1659 x 2212 pixels. Acquired with a Remidio FOP fundus camera. Color fundus image:
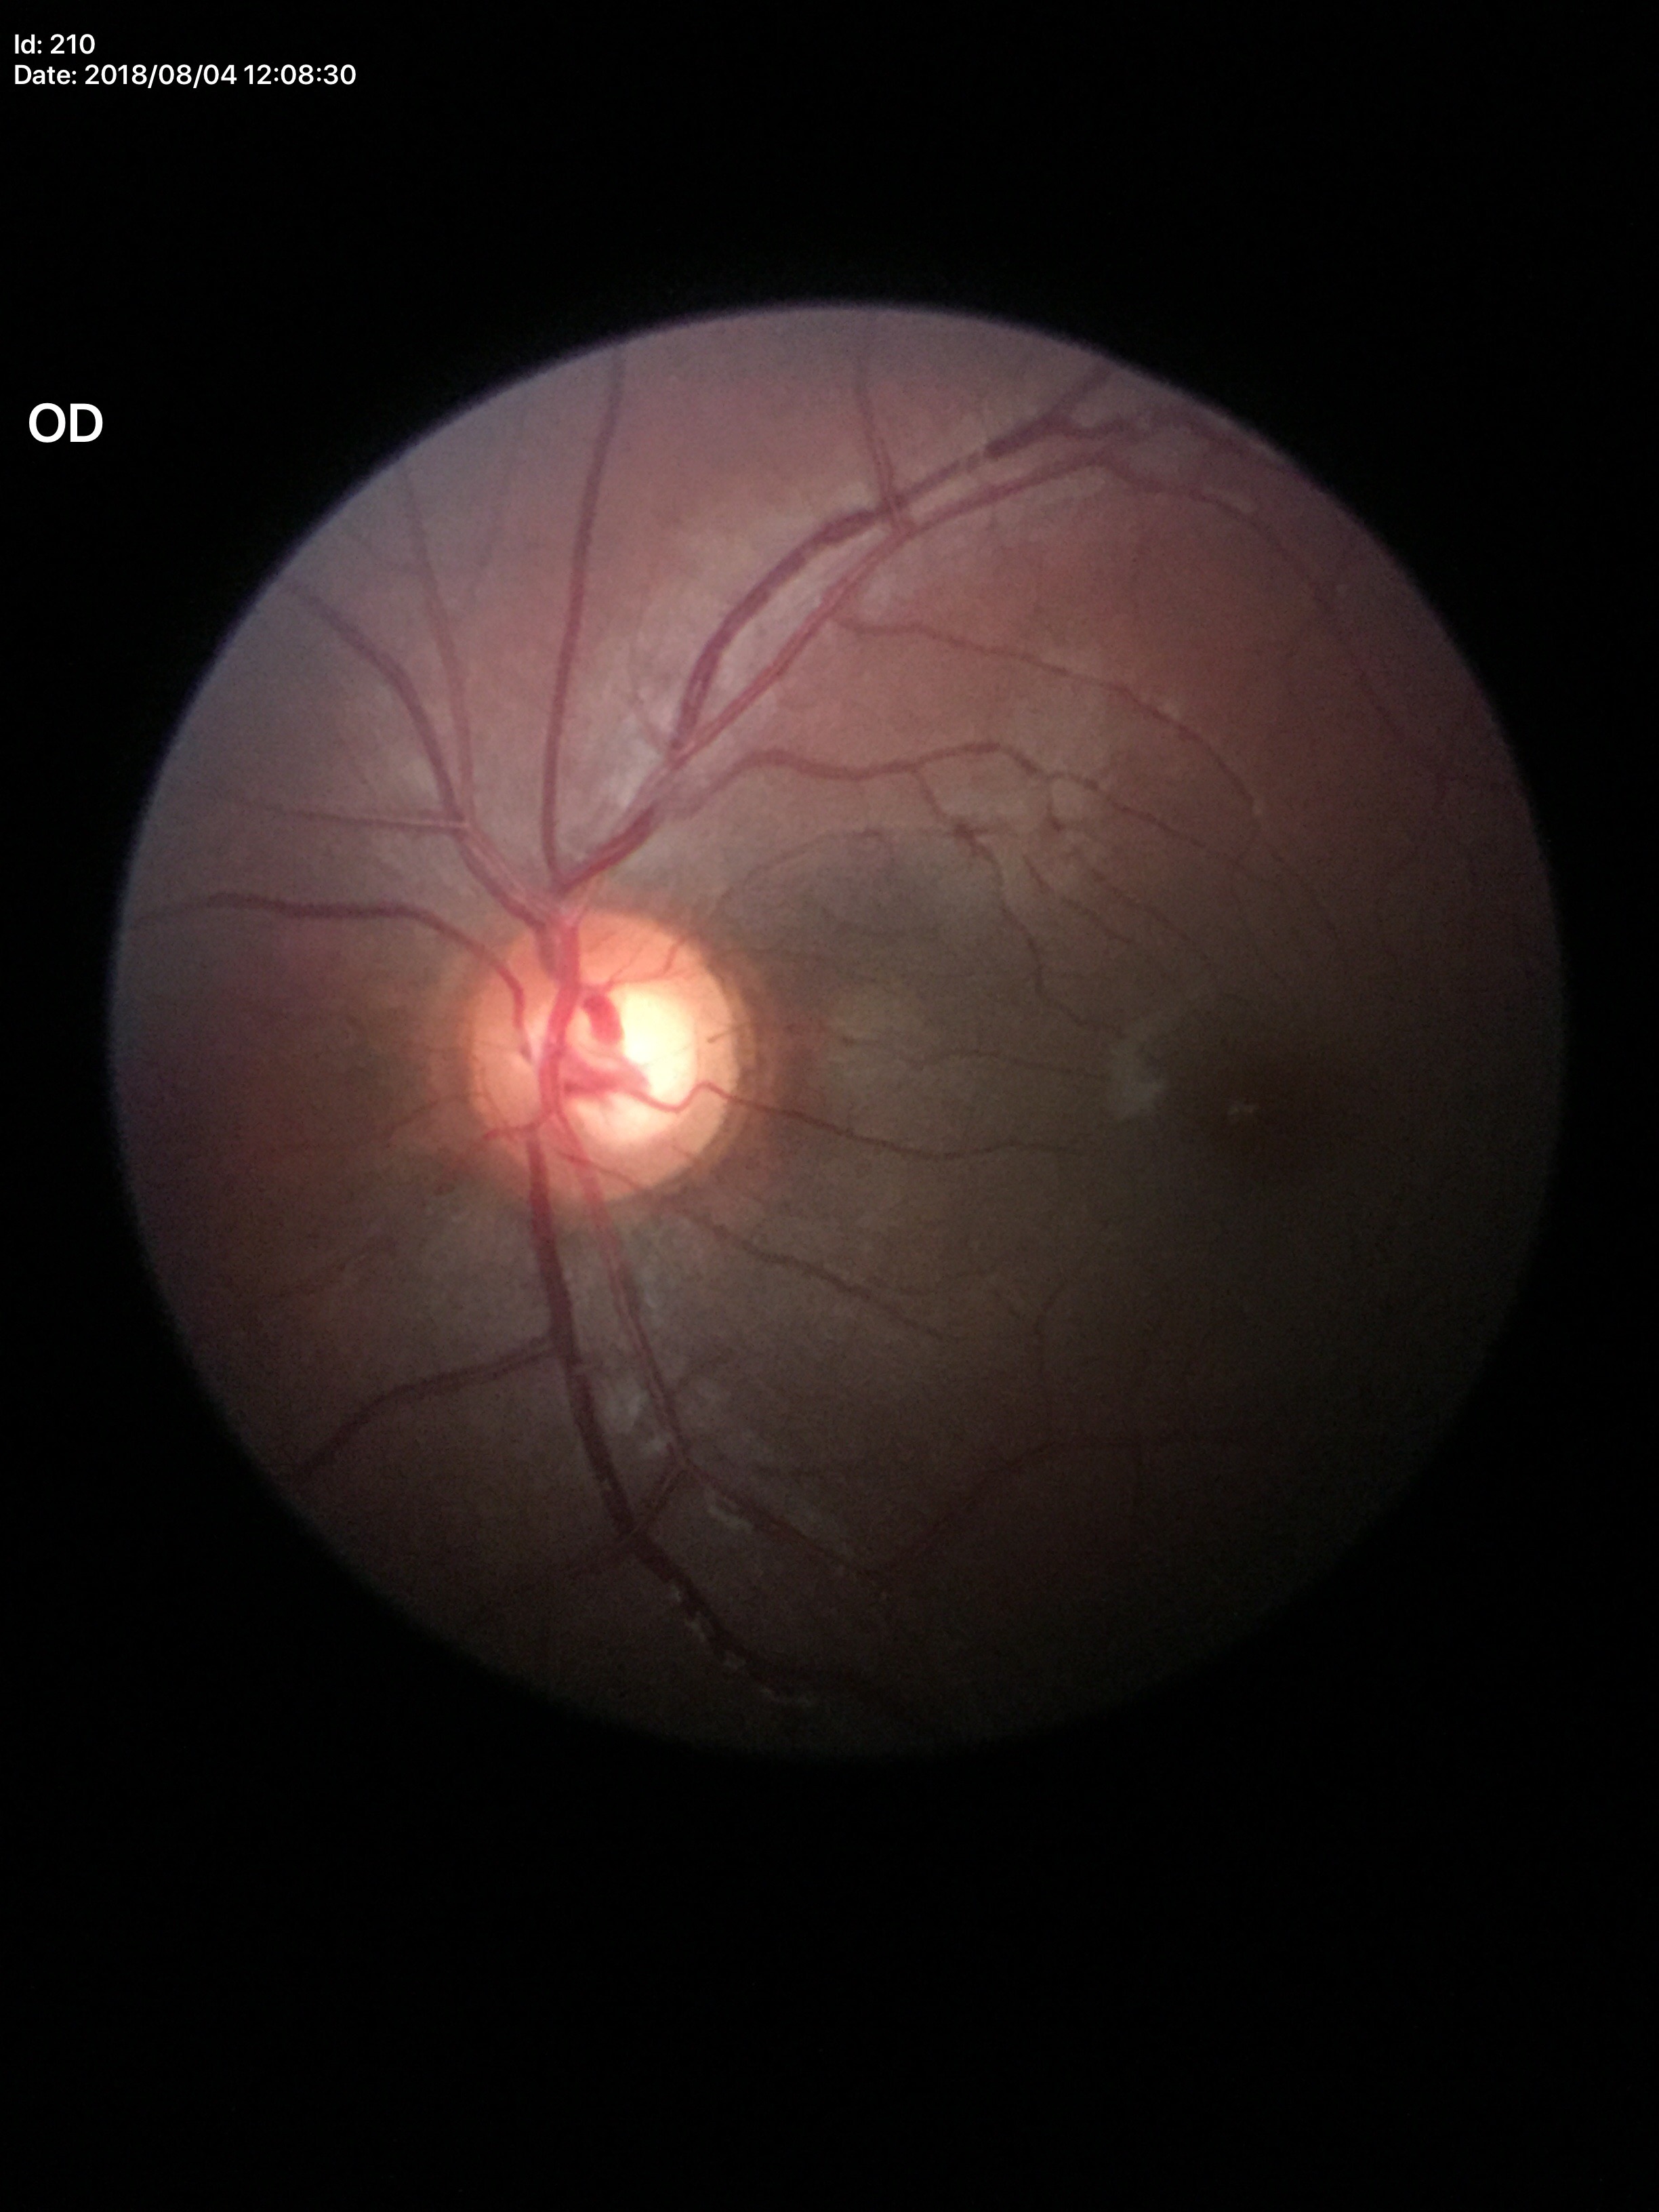 Optic disc analysis:
* horizontal C/D ratio (HCDR) · 0.65
* vertical cup-to-disc ratio (VCDR) · 0.60
* Glaucoma screening impression · suspicious (3/5 graders called glaucoma suspect)